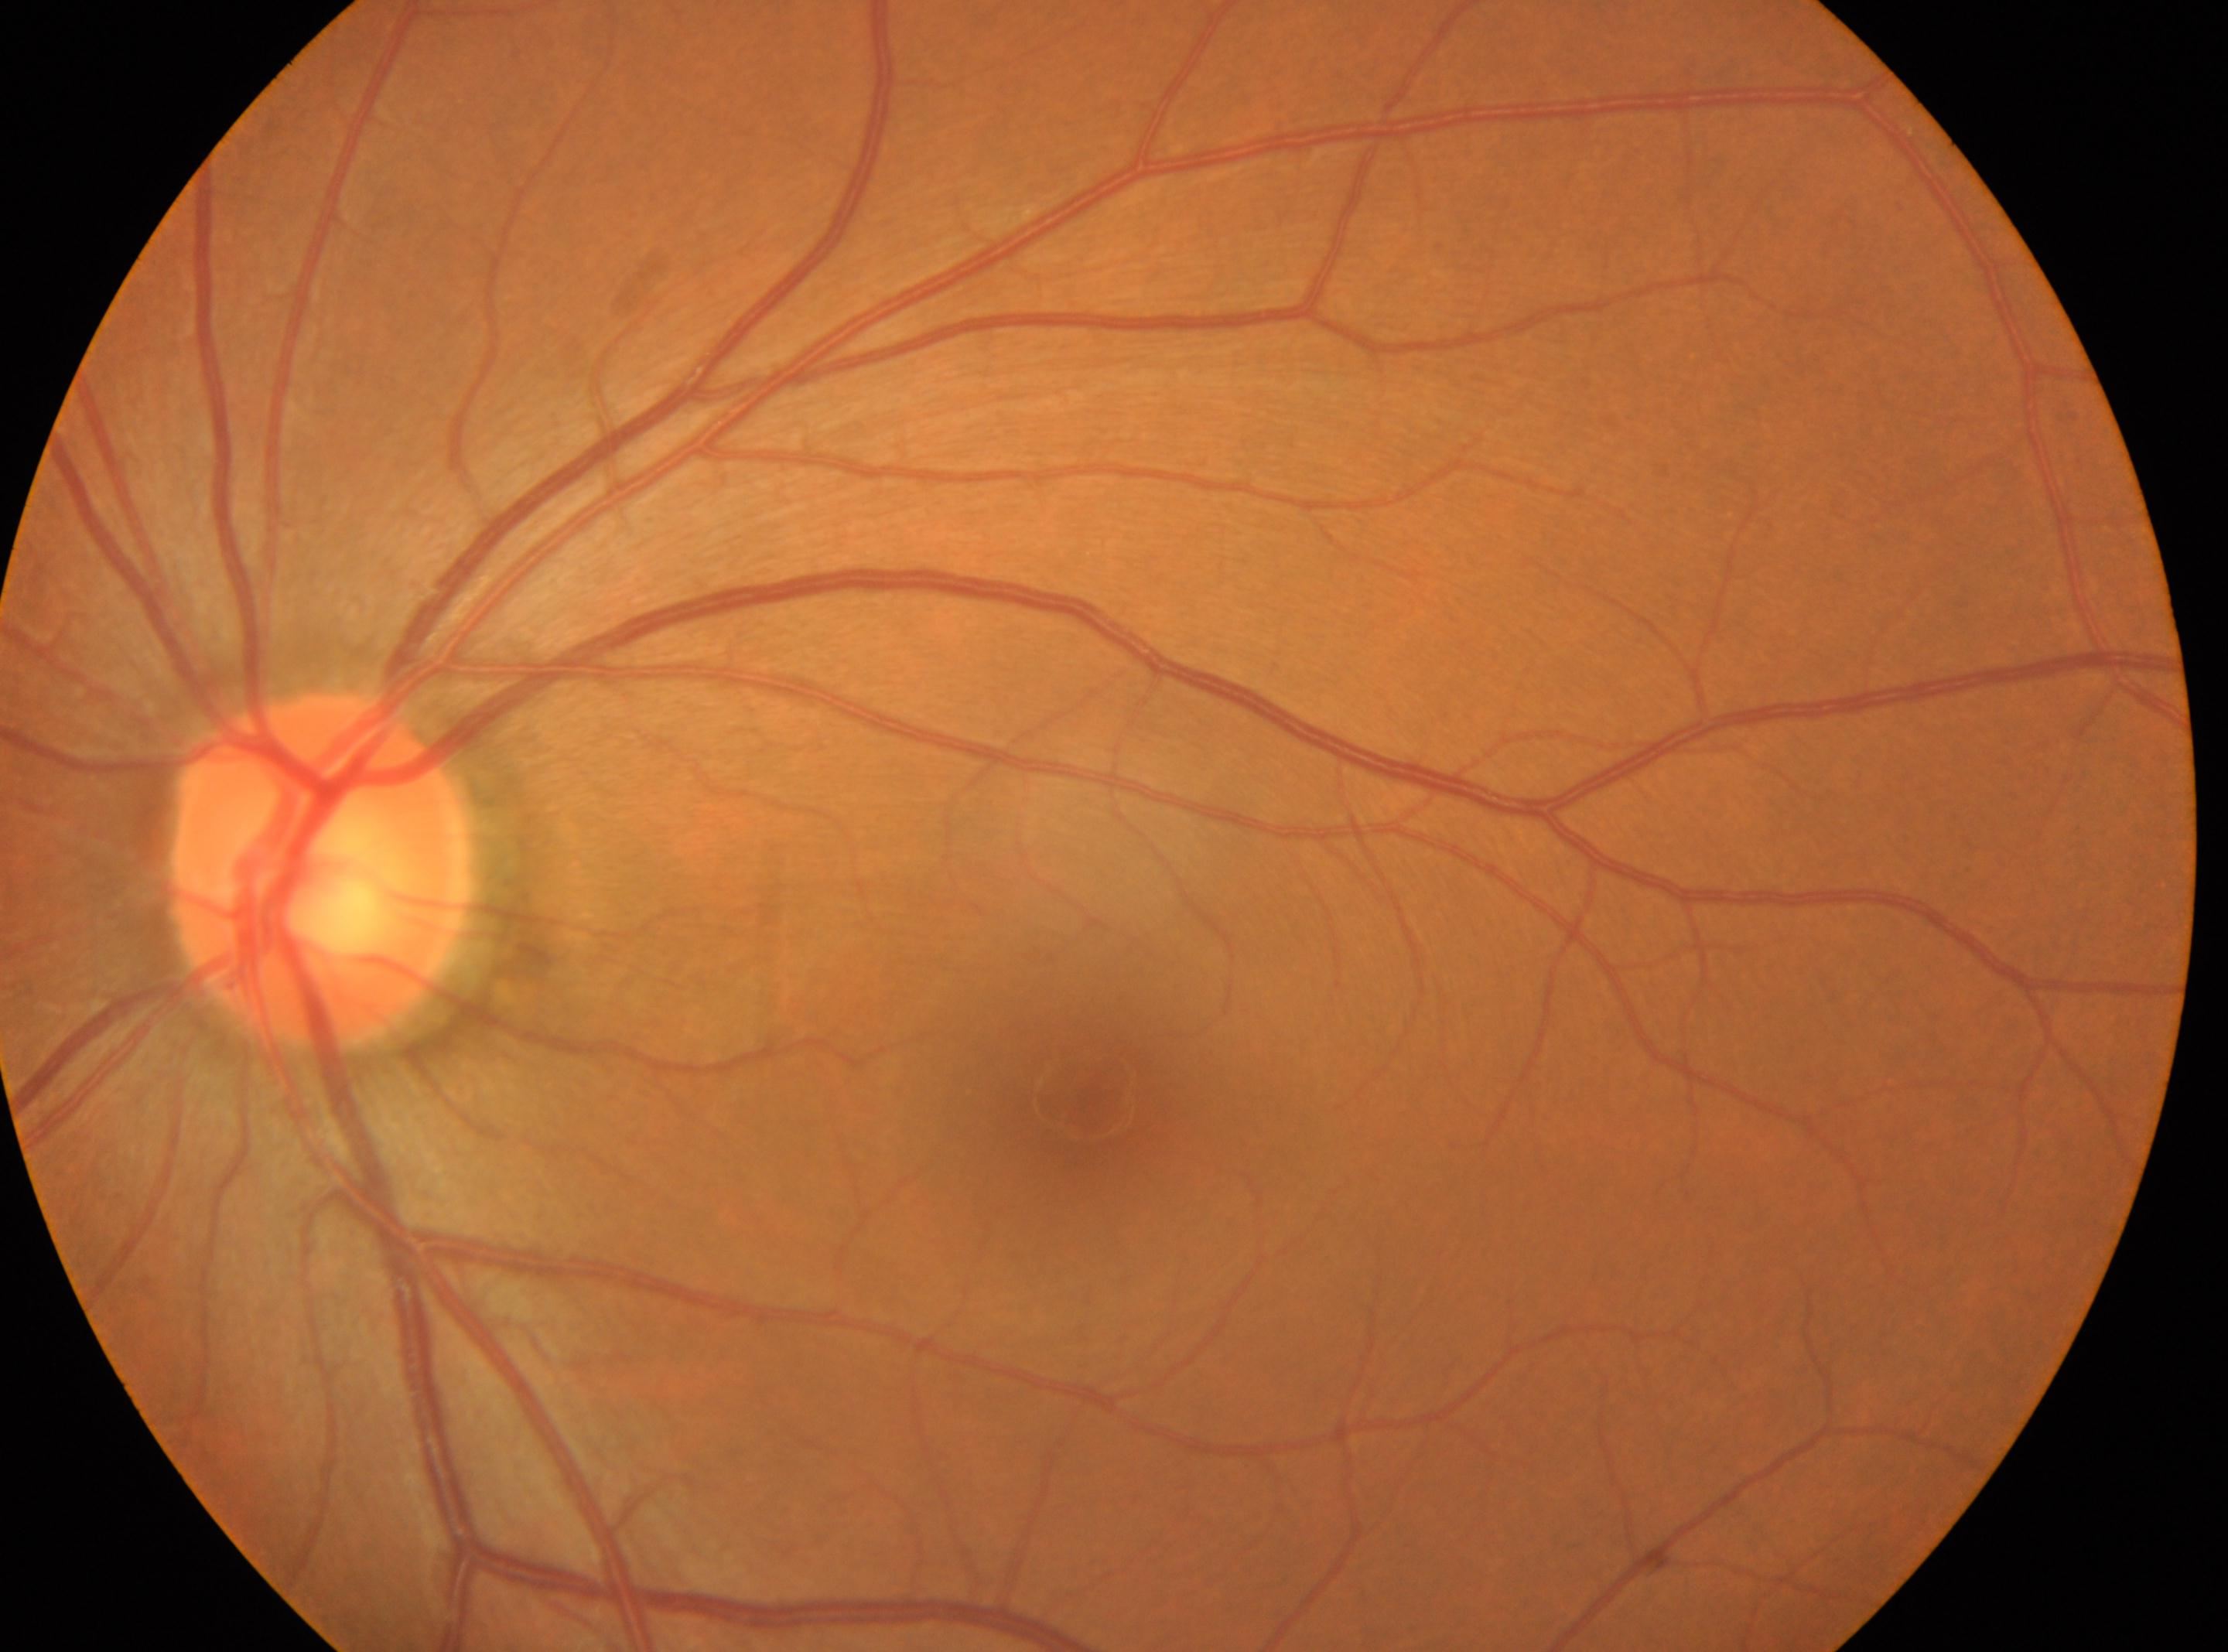

The macular center is at x=1094, y=1104. Diabetic retinopathy (DR) is 0. Eye: left eye. No diabetic retinal disease findings. The optic nerve head is at x=319, y=869.